ONH-centered crop from a color fundus image:
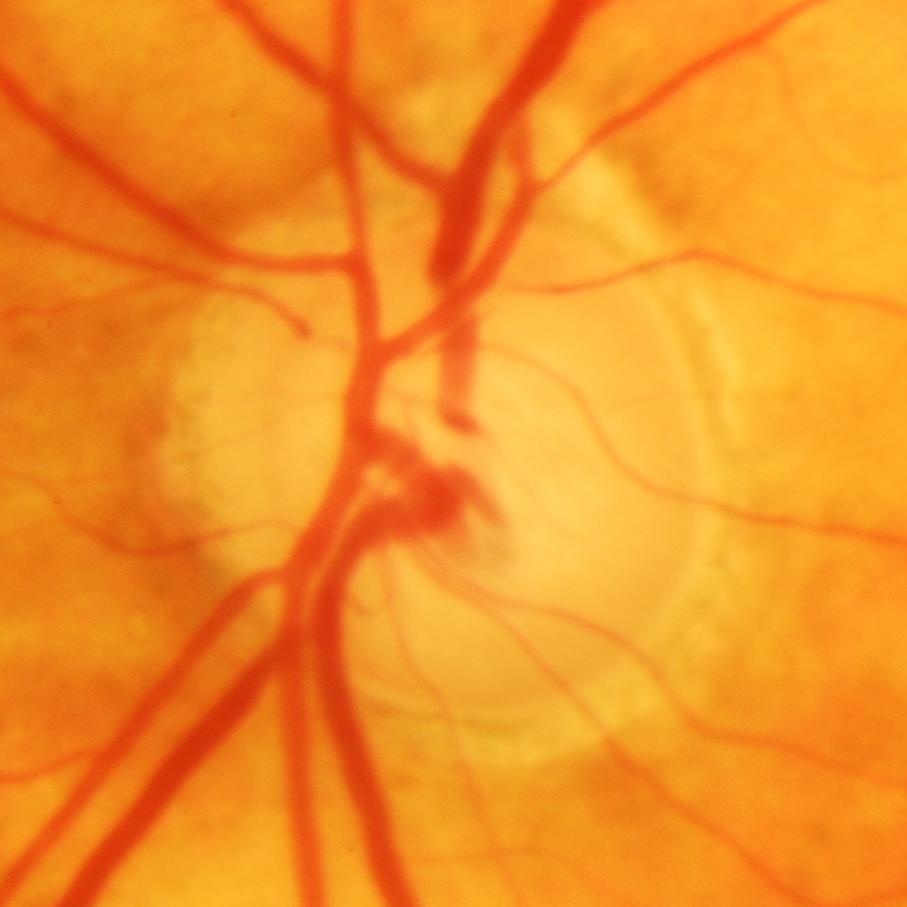 Finding = glaucomatous findings.